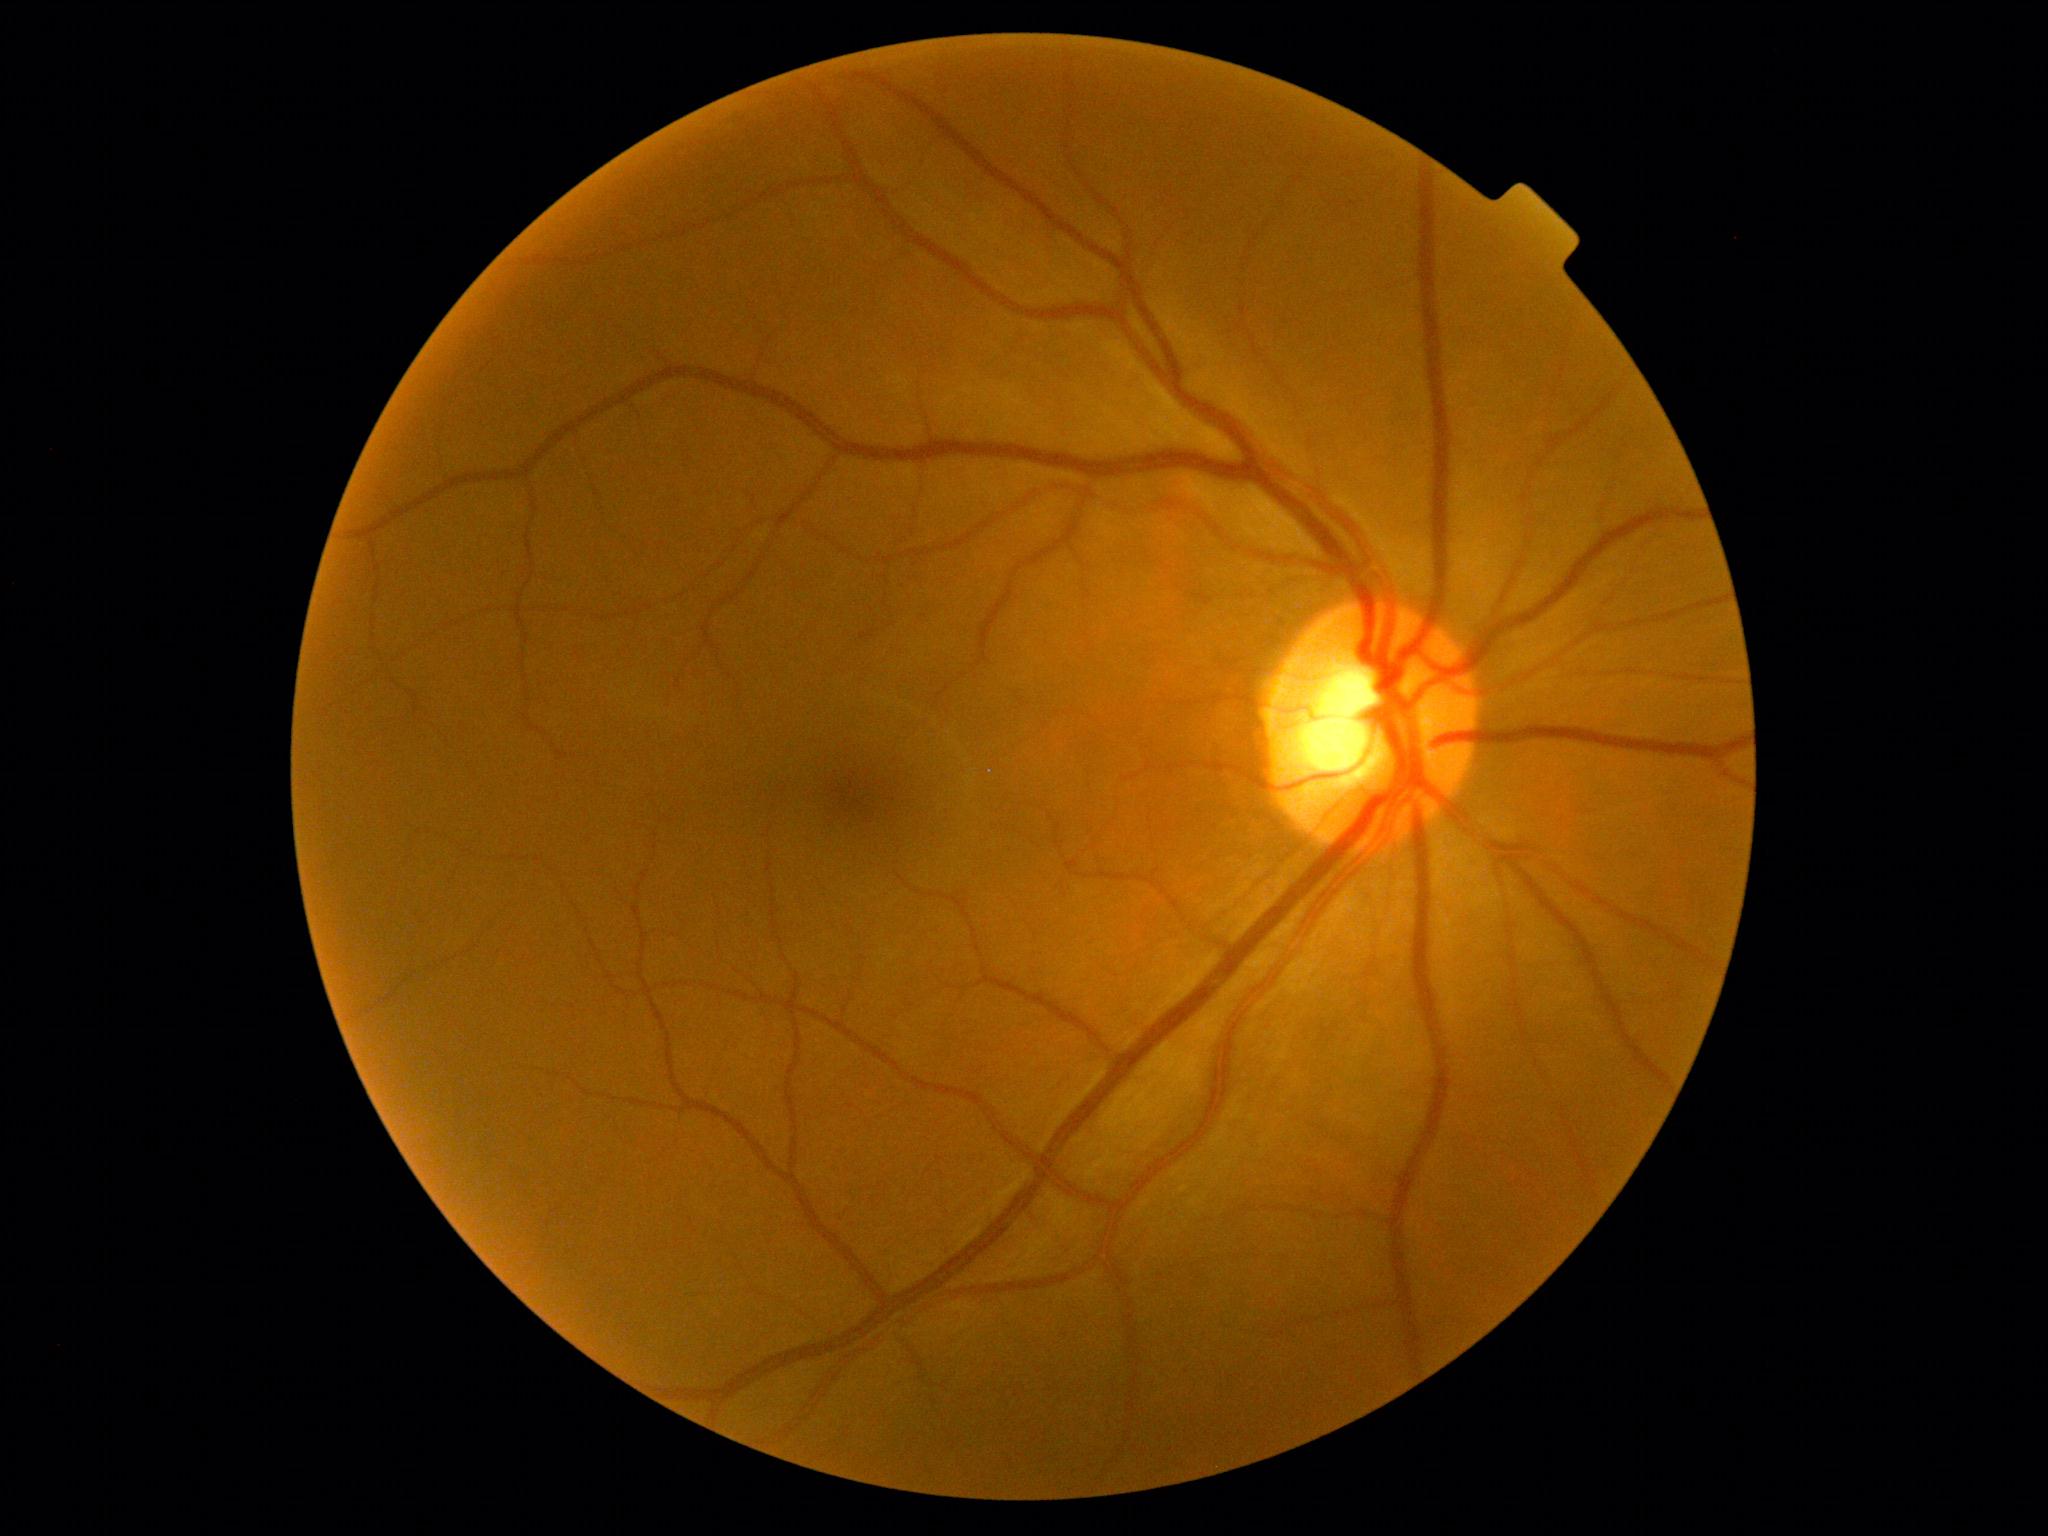
• retinopathy grade: no apparent retinopathy (0)